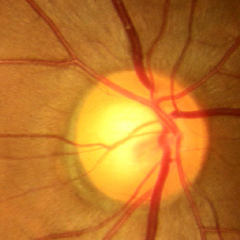
Fundus appearance consistent with no glaucomatous findings.